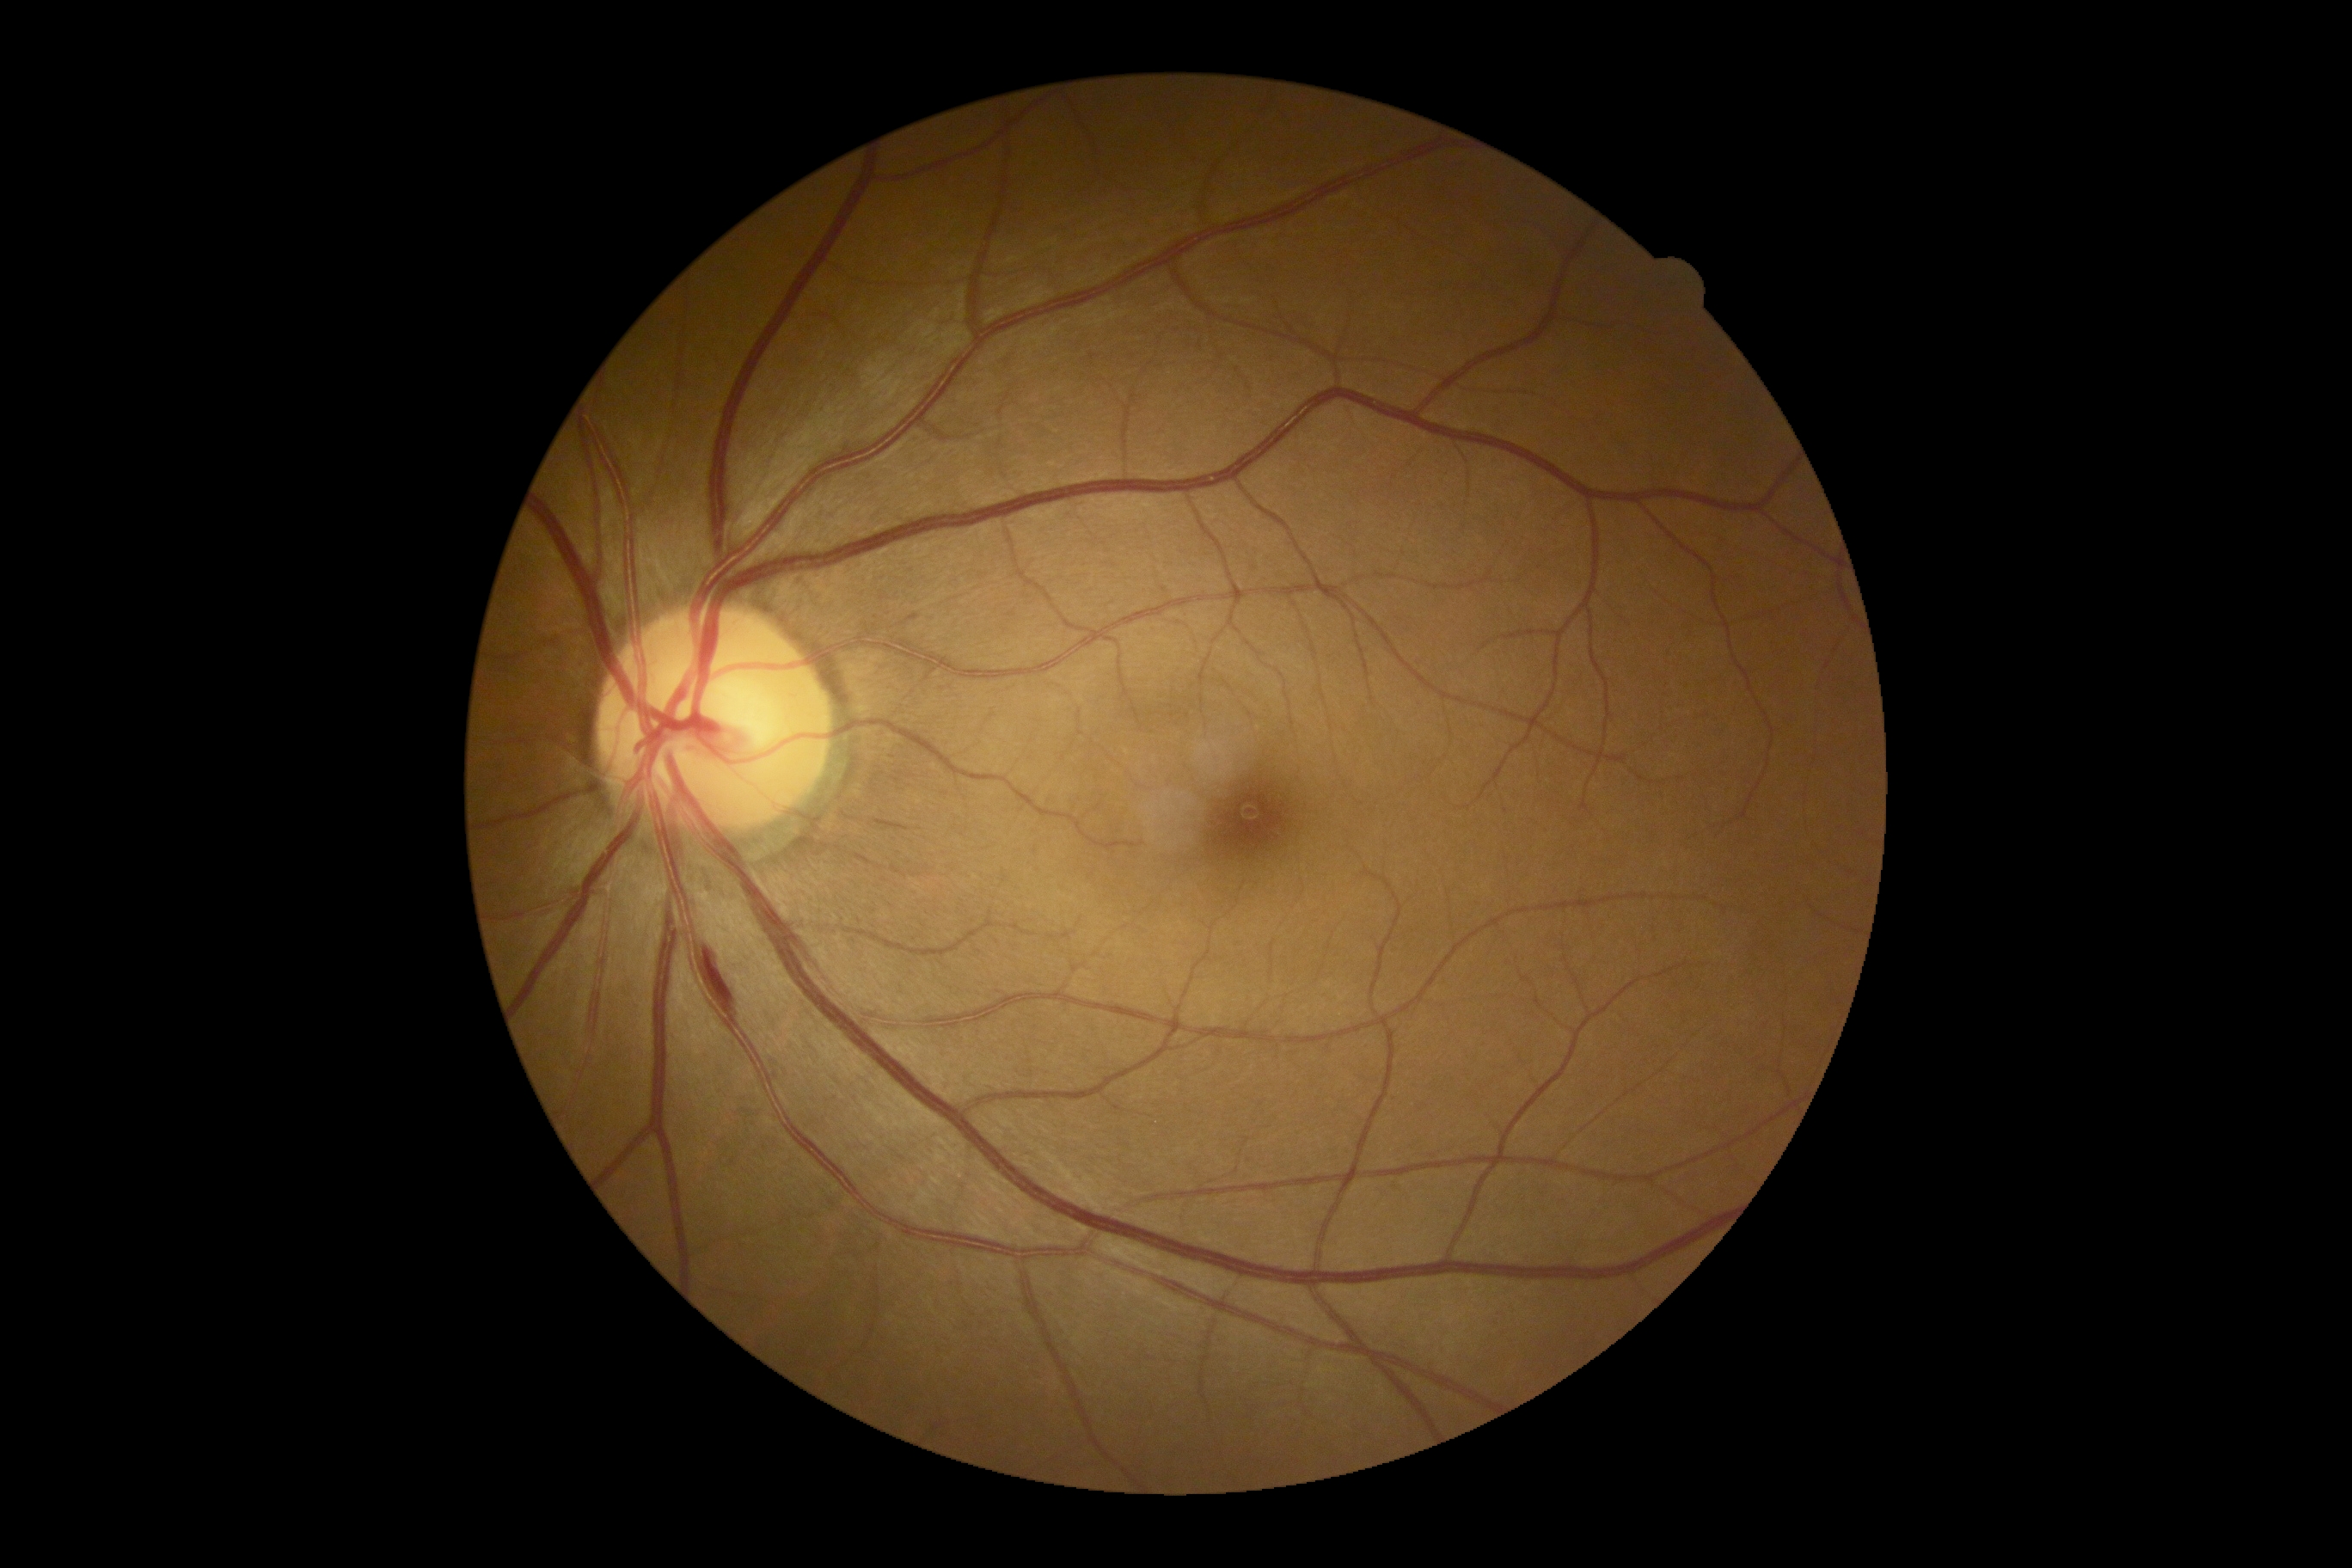 DR is moderate NPDR (grade 2).